1932x1916 — 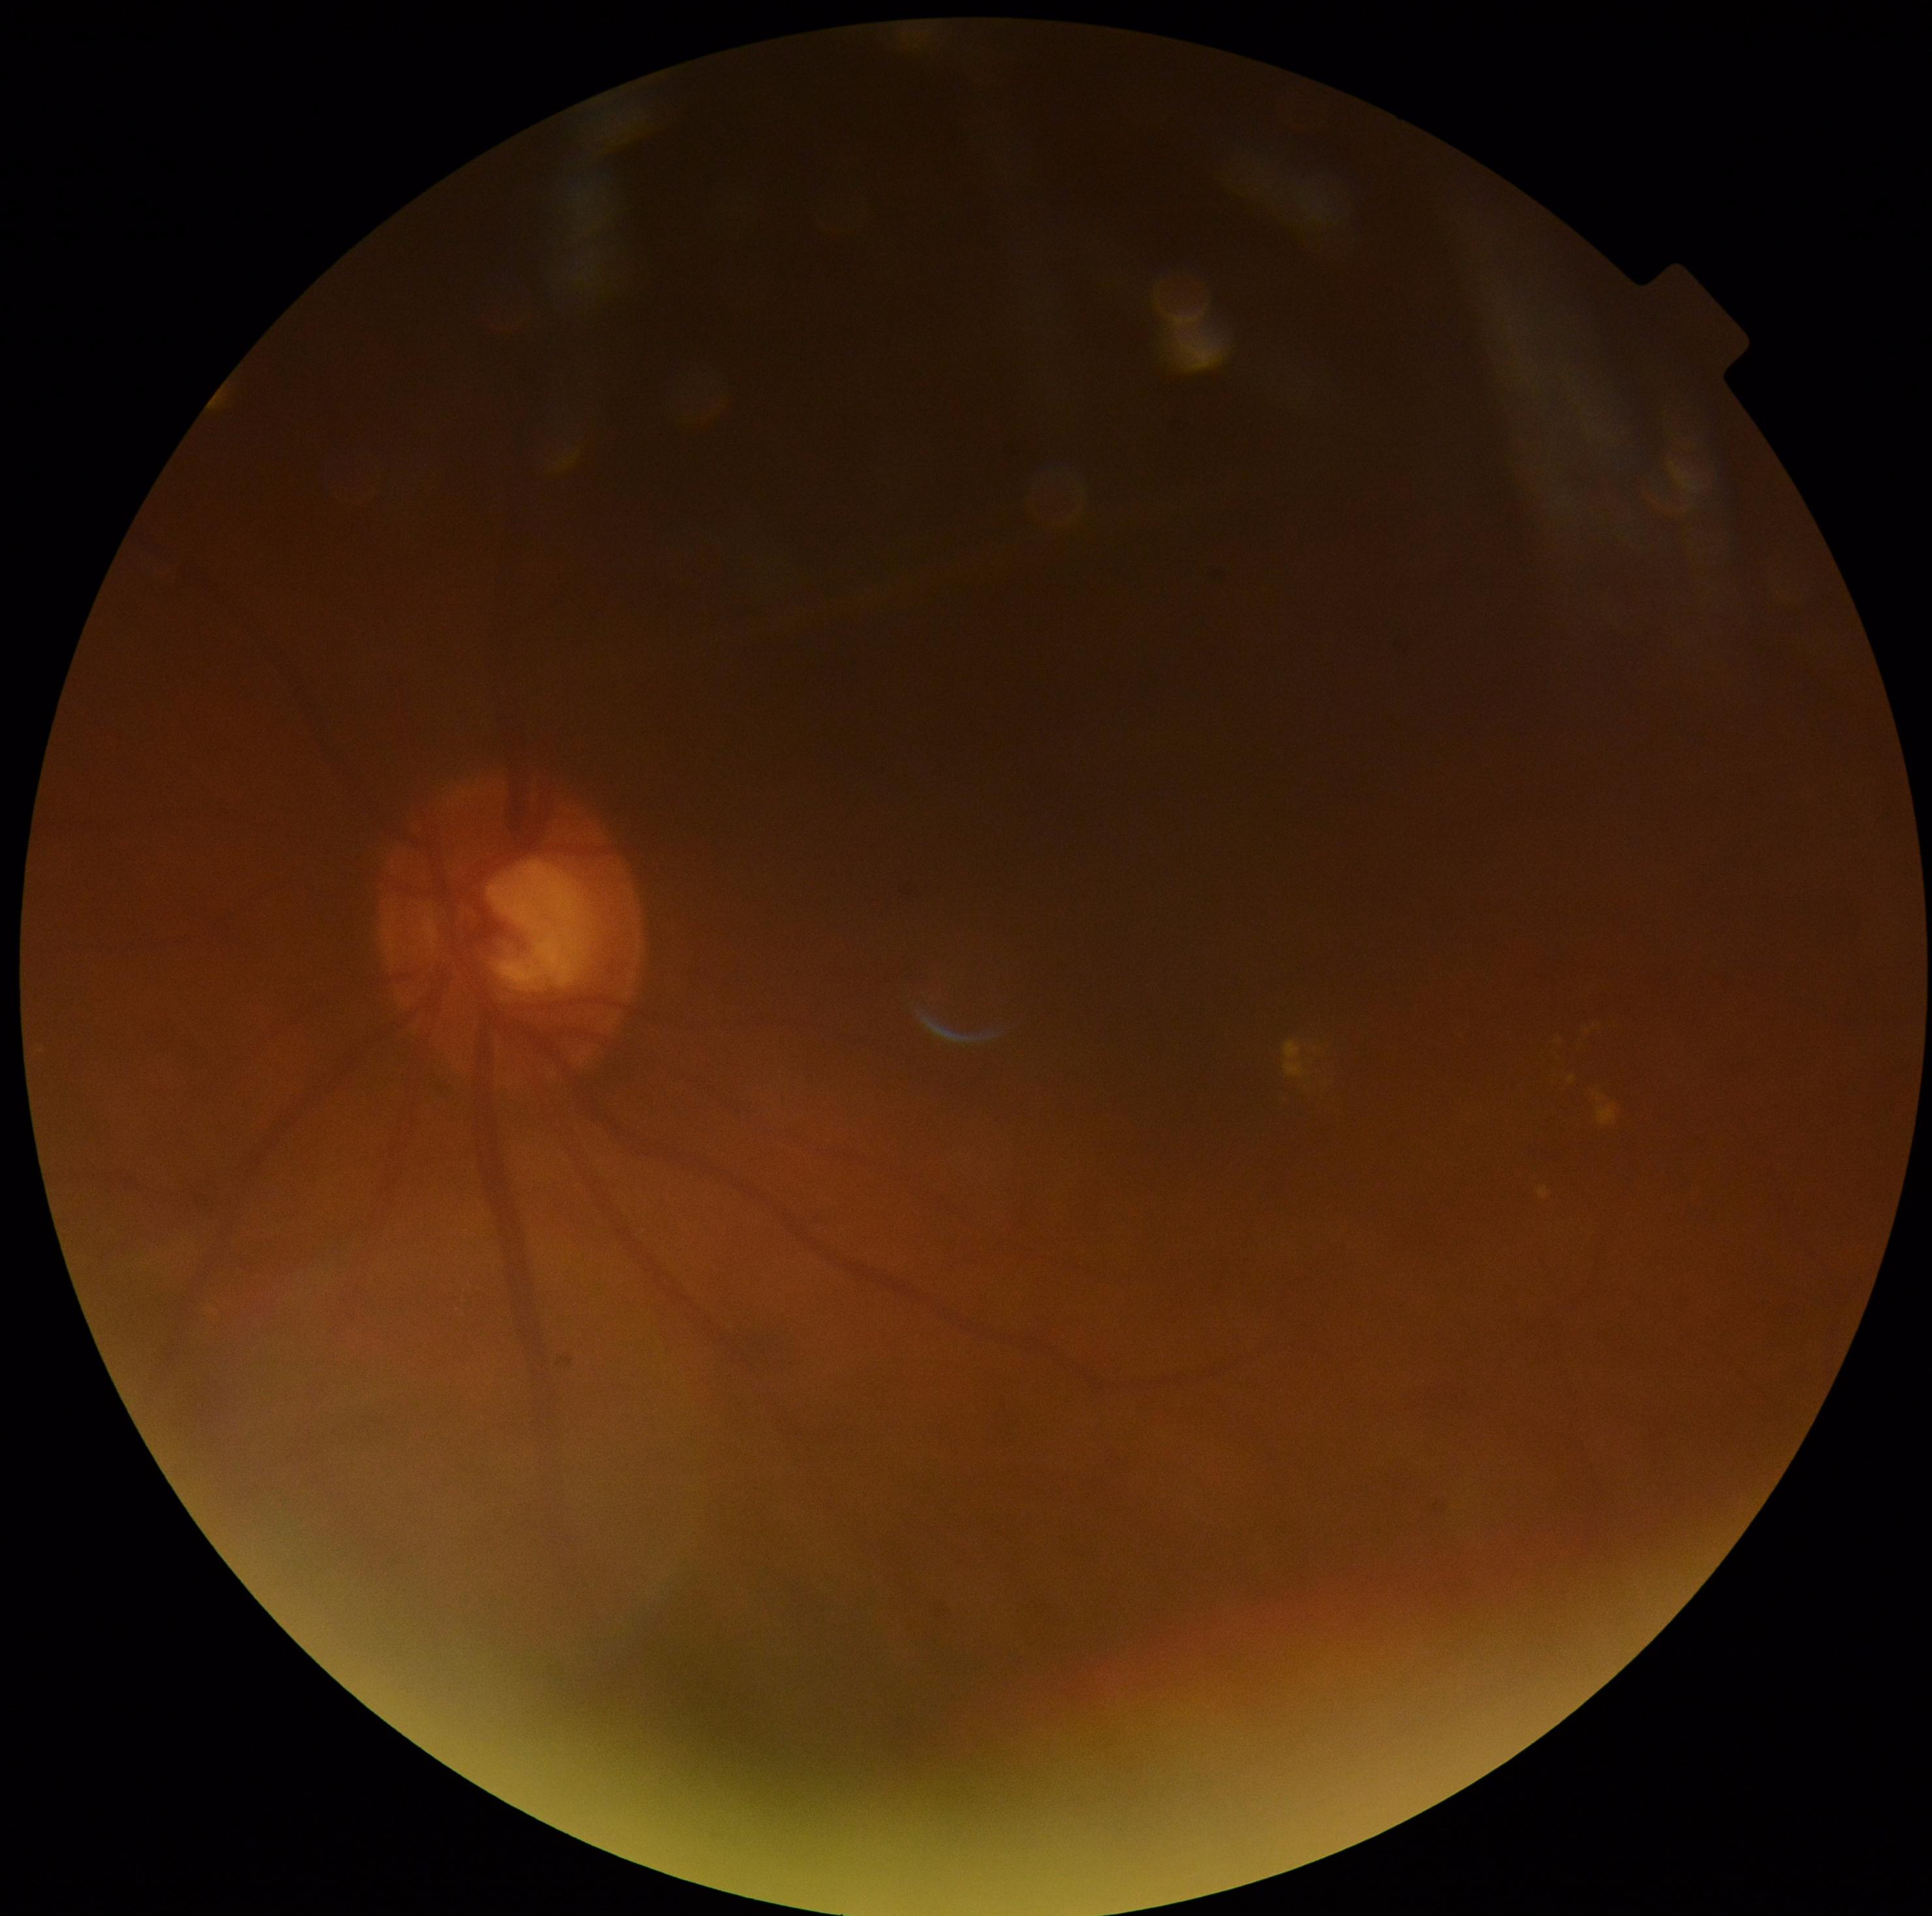
  dr_category: non-proliferative diabetic retinopathy
  dr_grade: grade 2 (moderate NPDR)